Camera: Phoenix ICON (100° FOV) · 1240x1240px · wide-field contact fundus photograph of an infant: 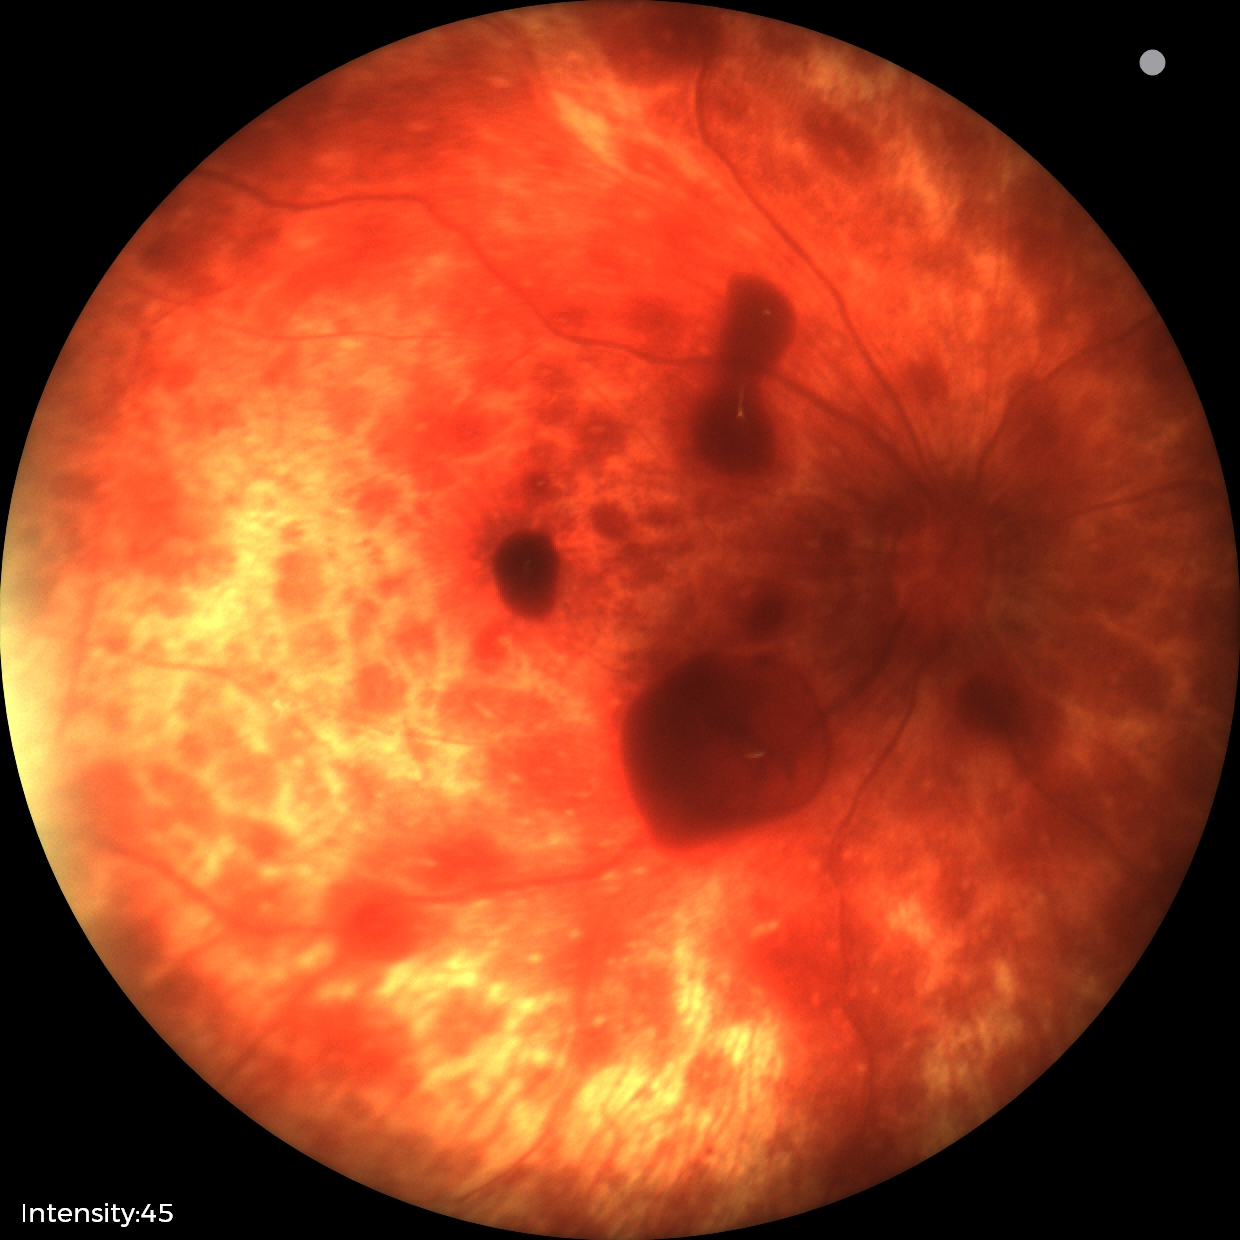 Finding = retinal hemorrhages.